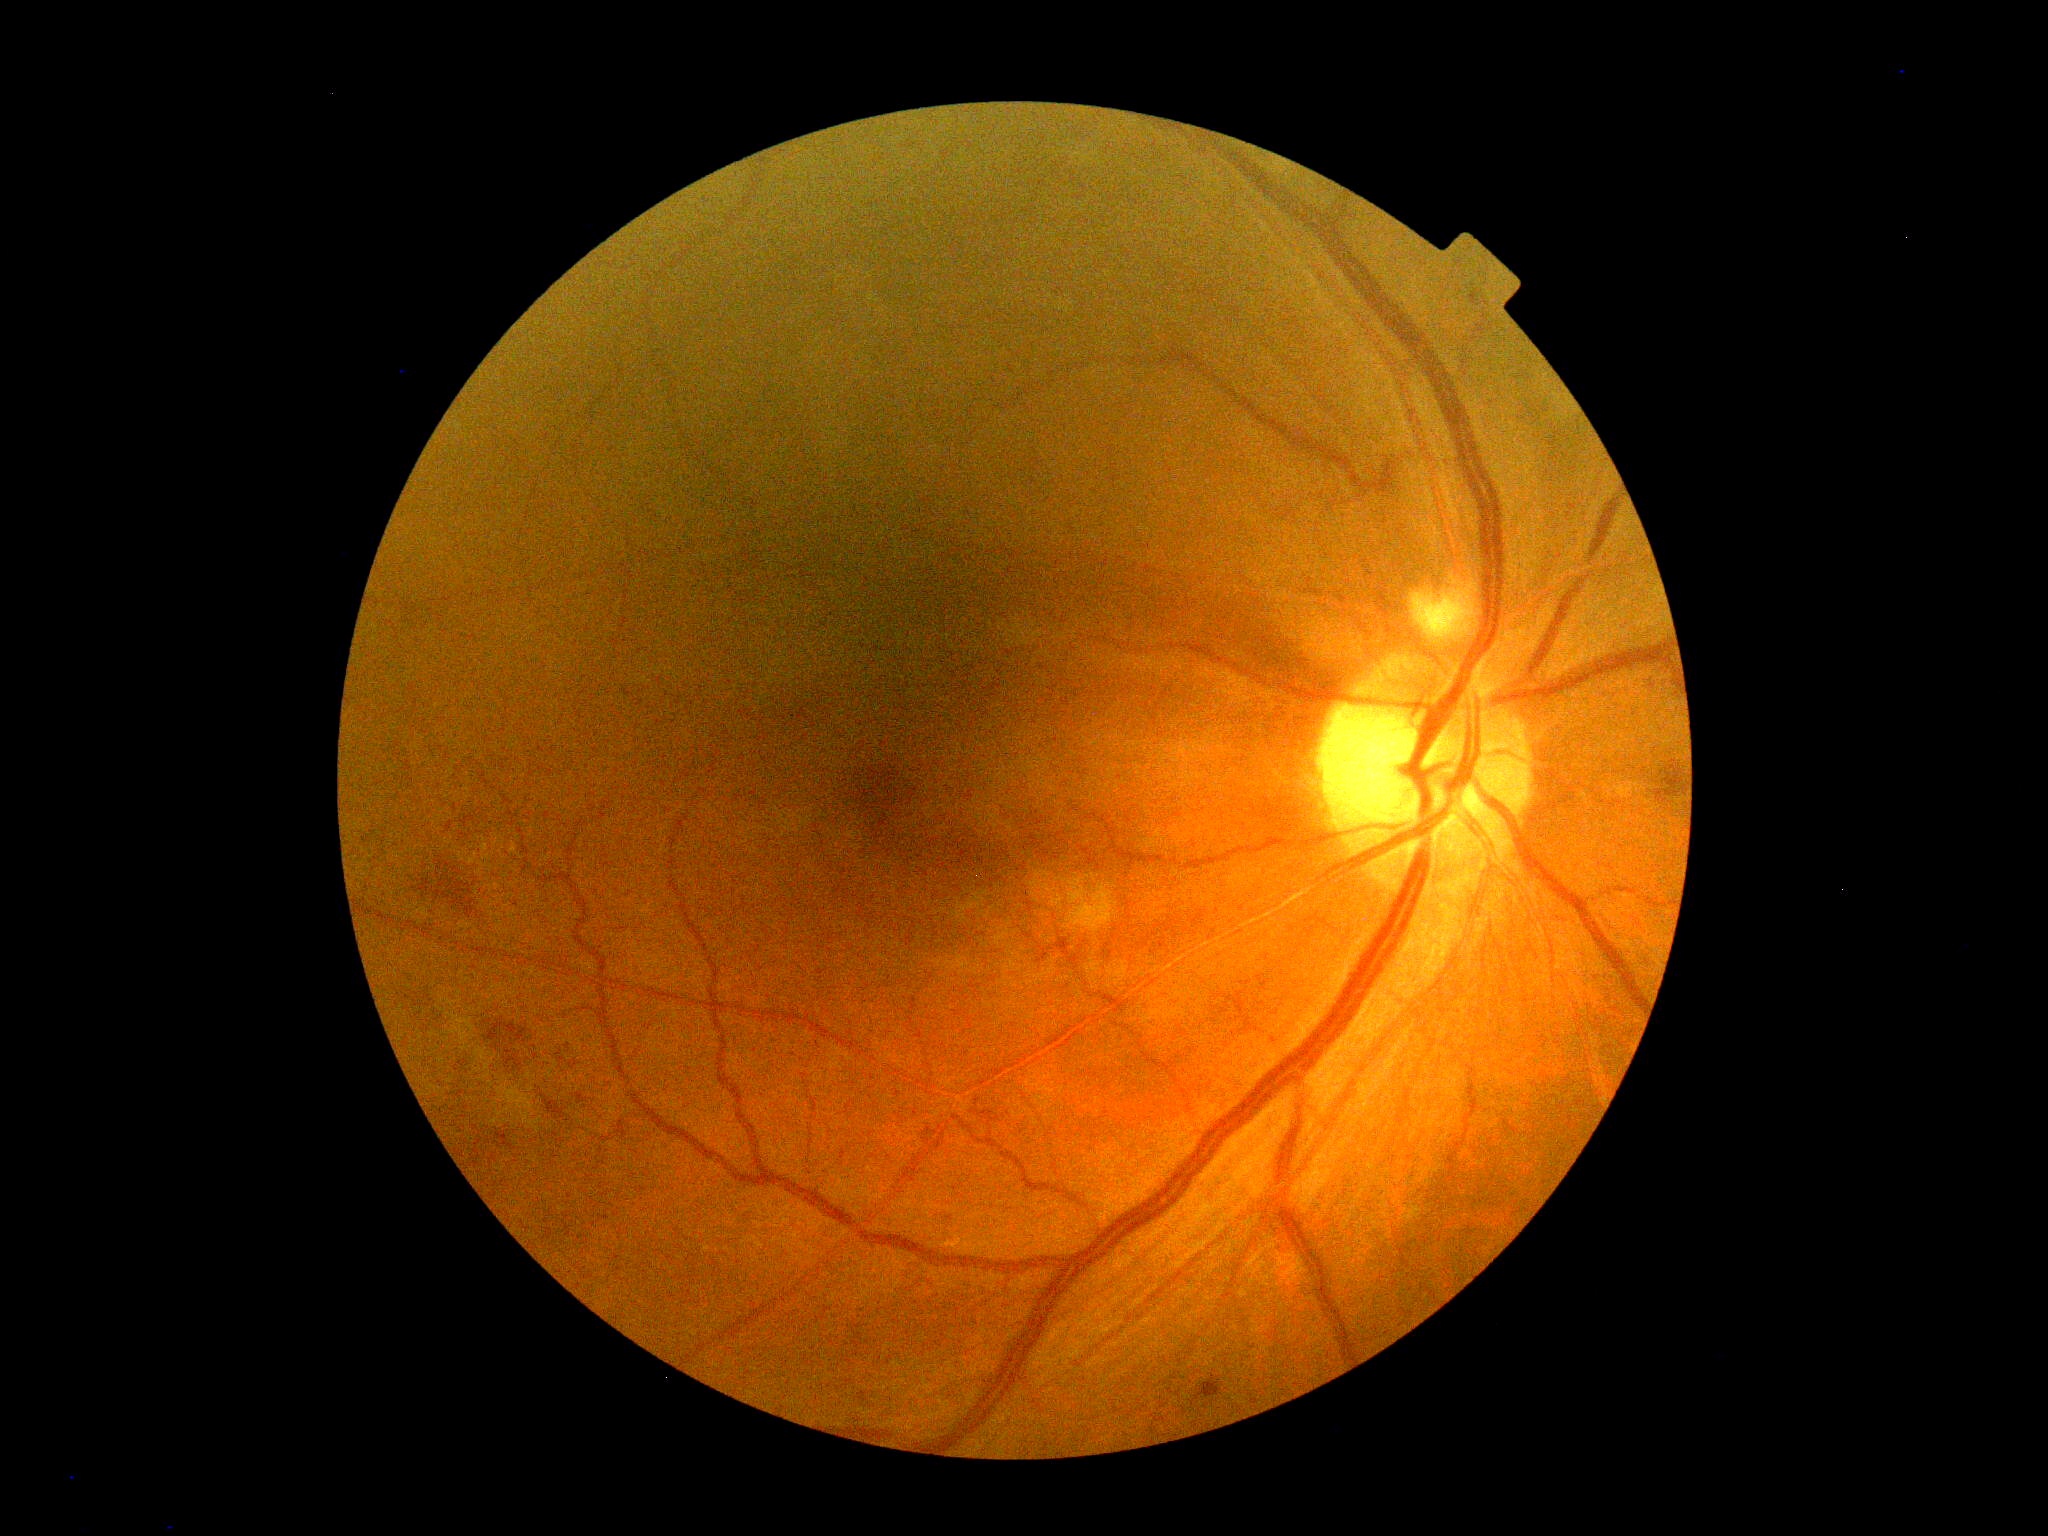

diabetic retinopathy (DR): grade 2 (moderate NPDR).